848x848px. Posterior pole color fundus photograph. Acquired with a NIDEK AFC-230. 45° field of view — 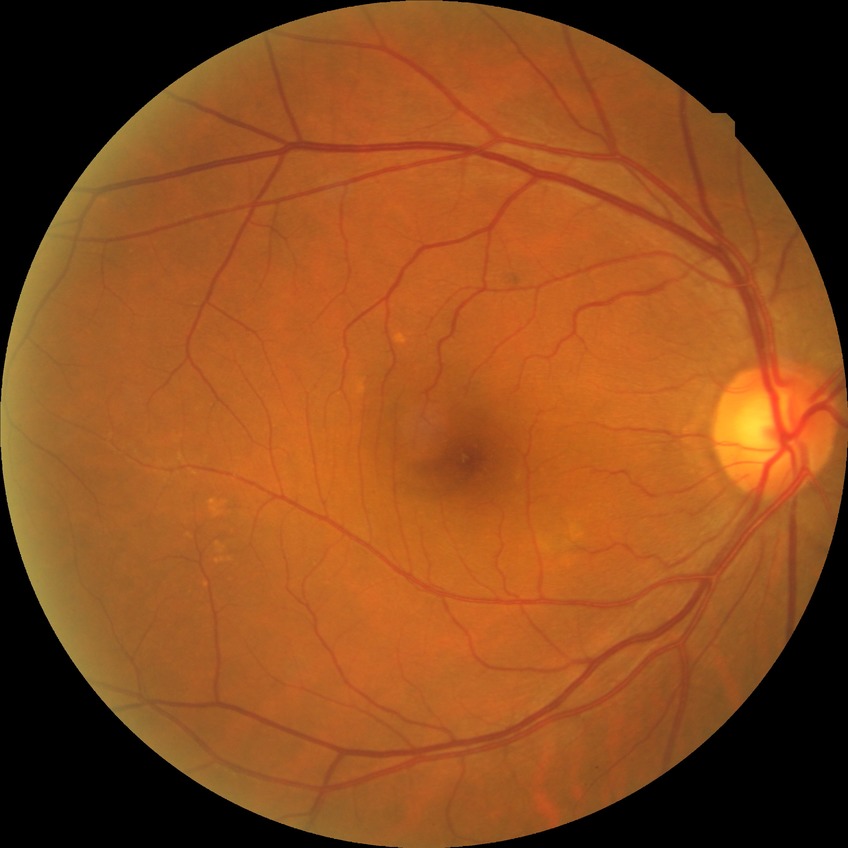 • diabetic retinopathy (DR) — no diabetic retinopathy (NDR)